2228 x 1652 pixels · acquired with a Topcon TRC-50DX · posterior pole field covering the optic disc and macula · dilated-pupil acquisition: 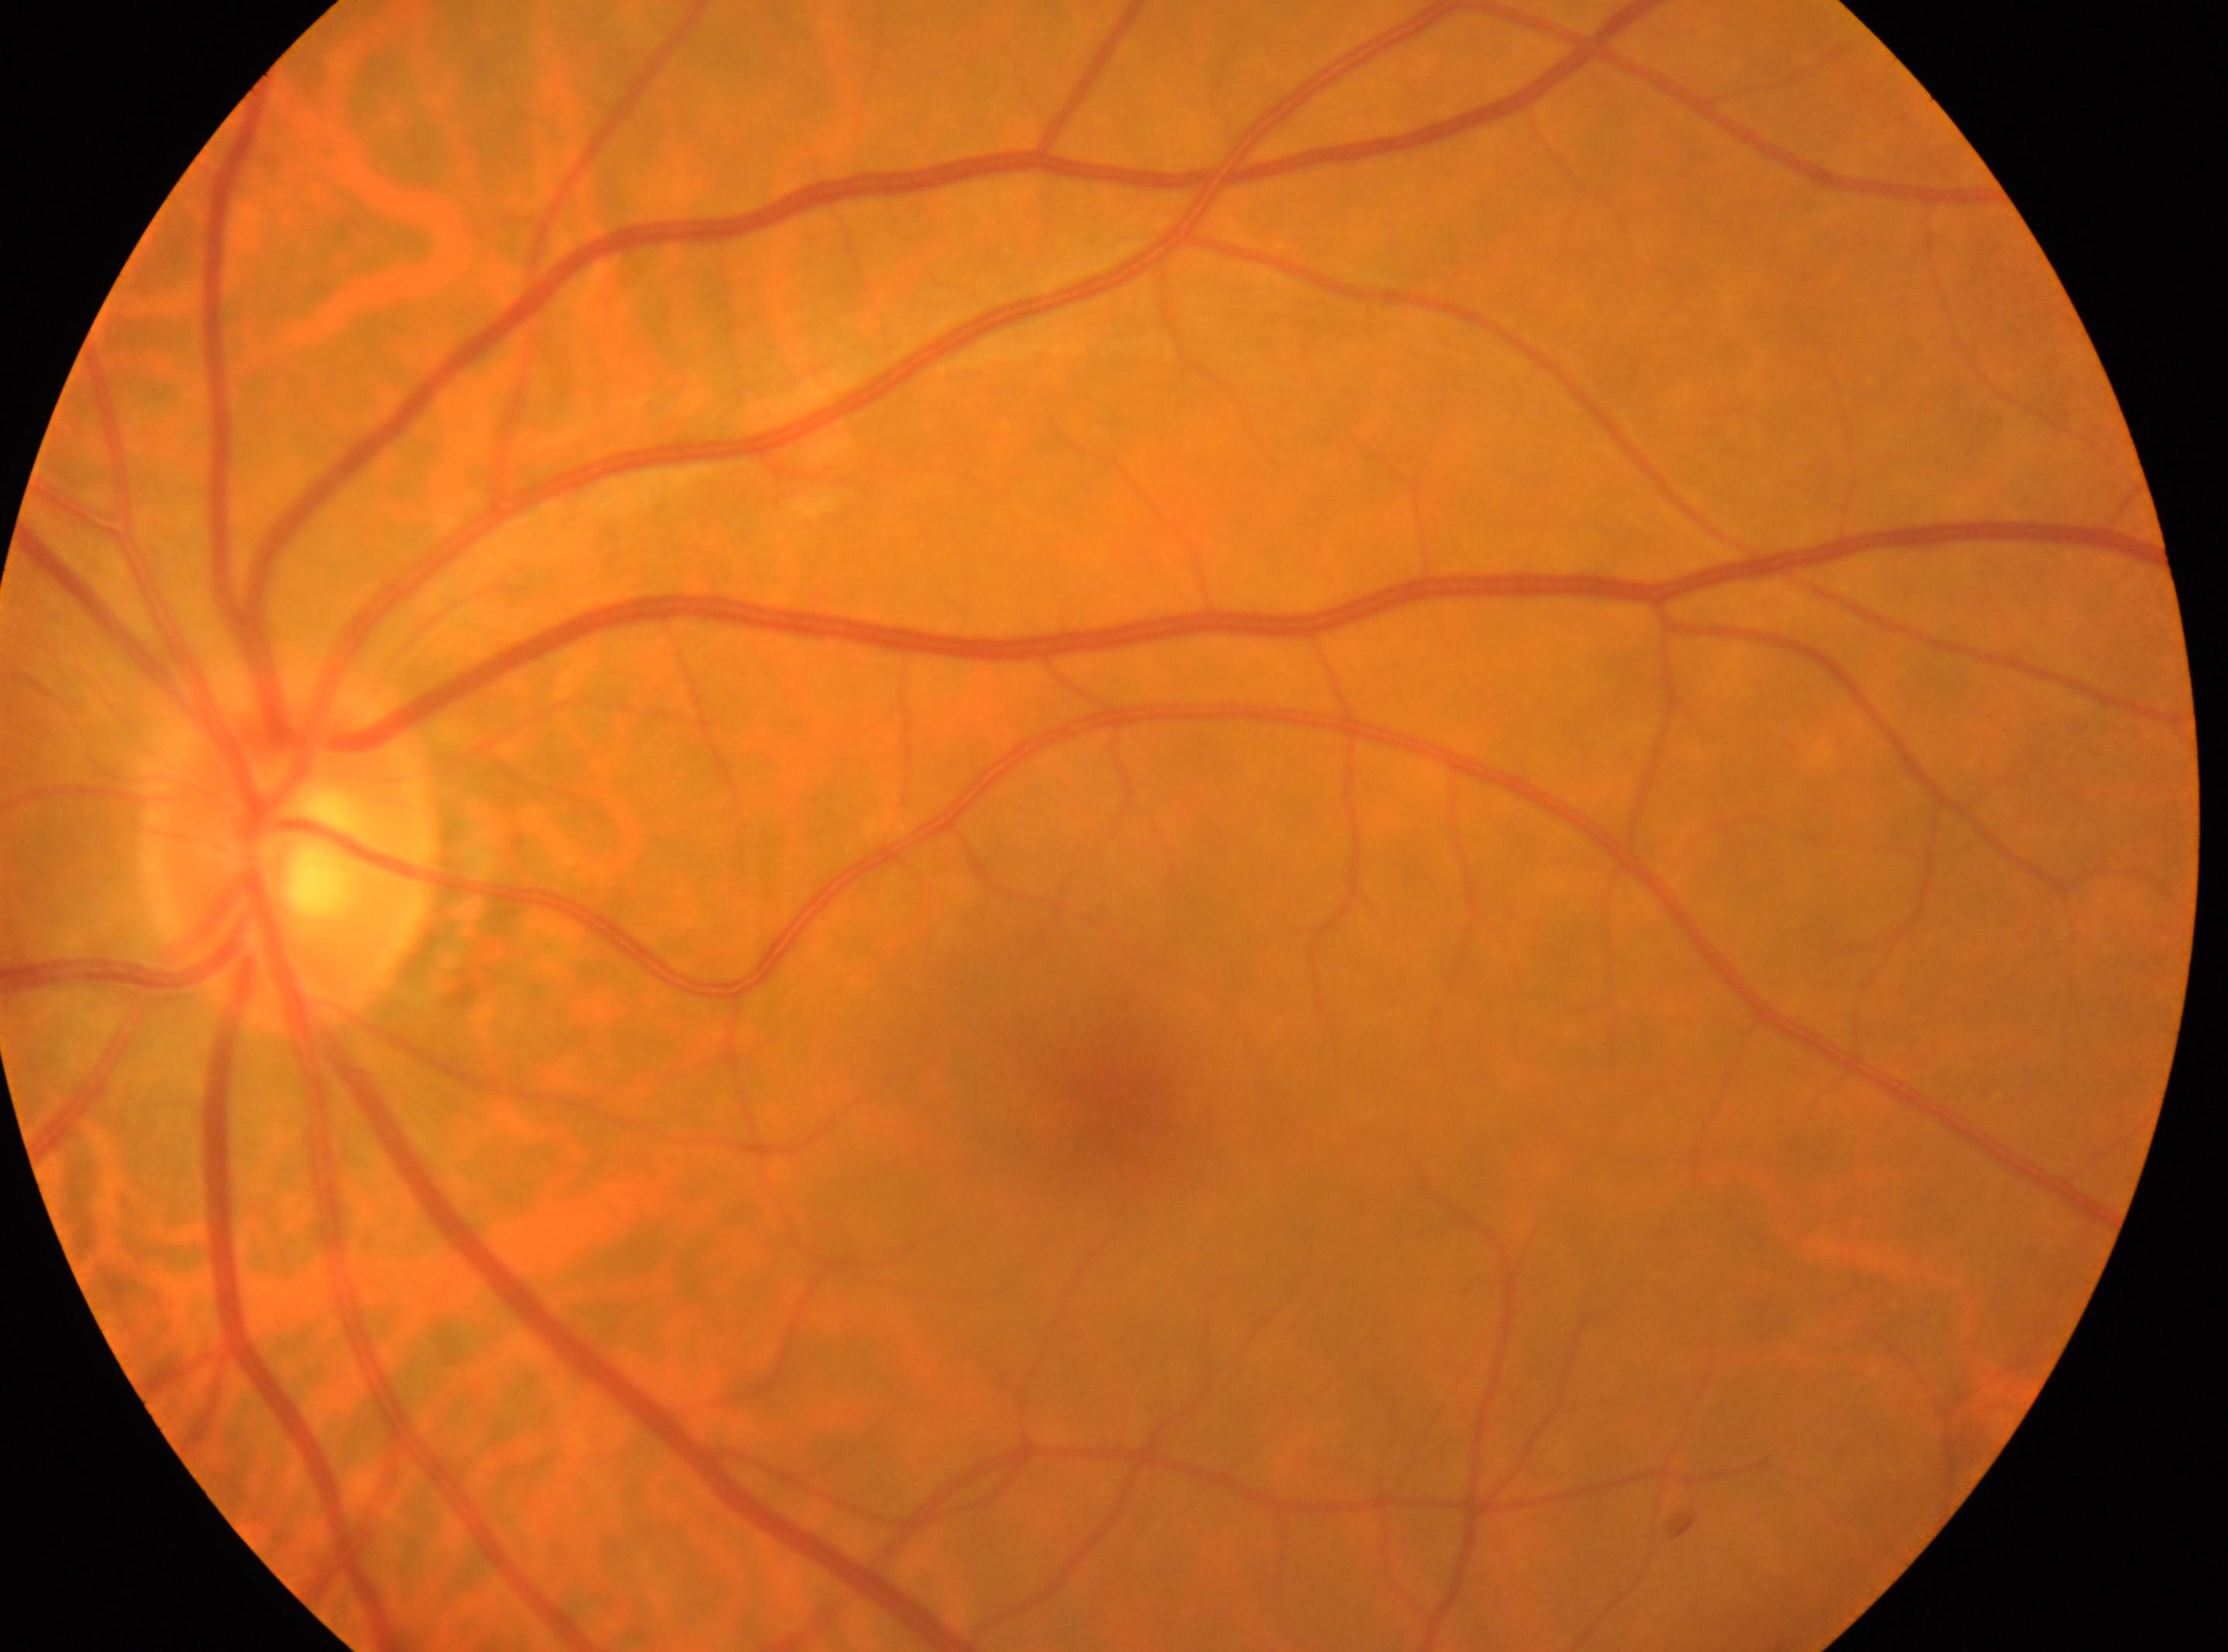

The fovea is at 1122px, 1097px.
Eye: left eye.
Diabetic retinopathy grade: 0.
The disc center is at 286px, 851px.